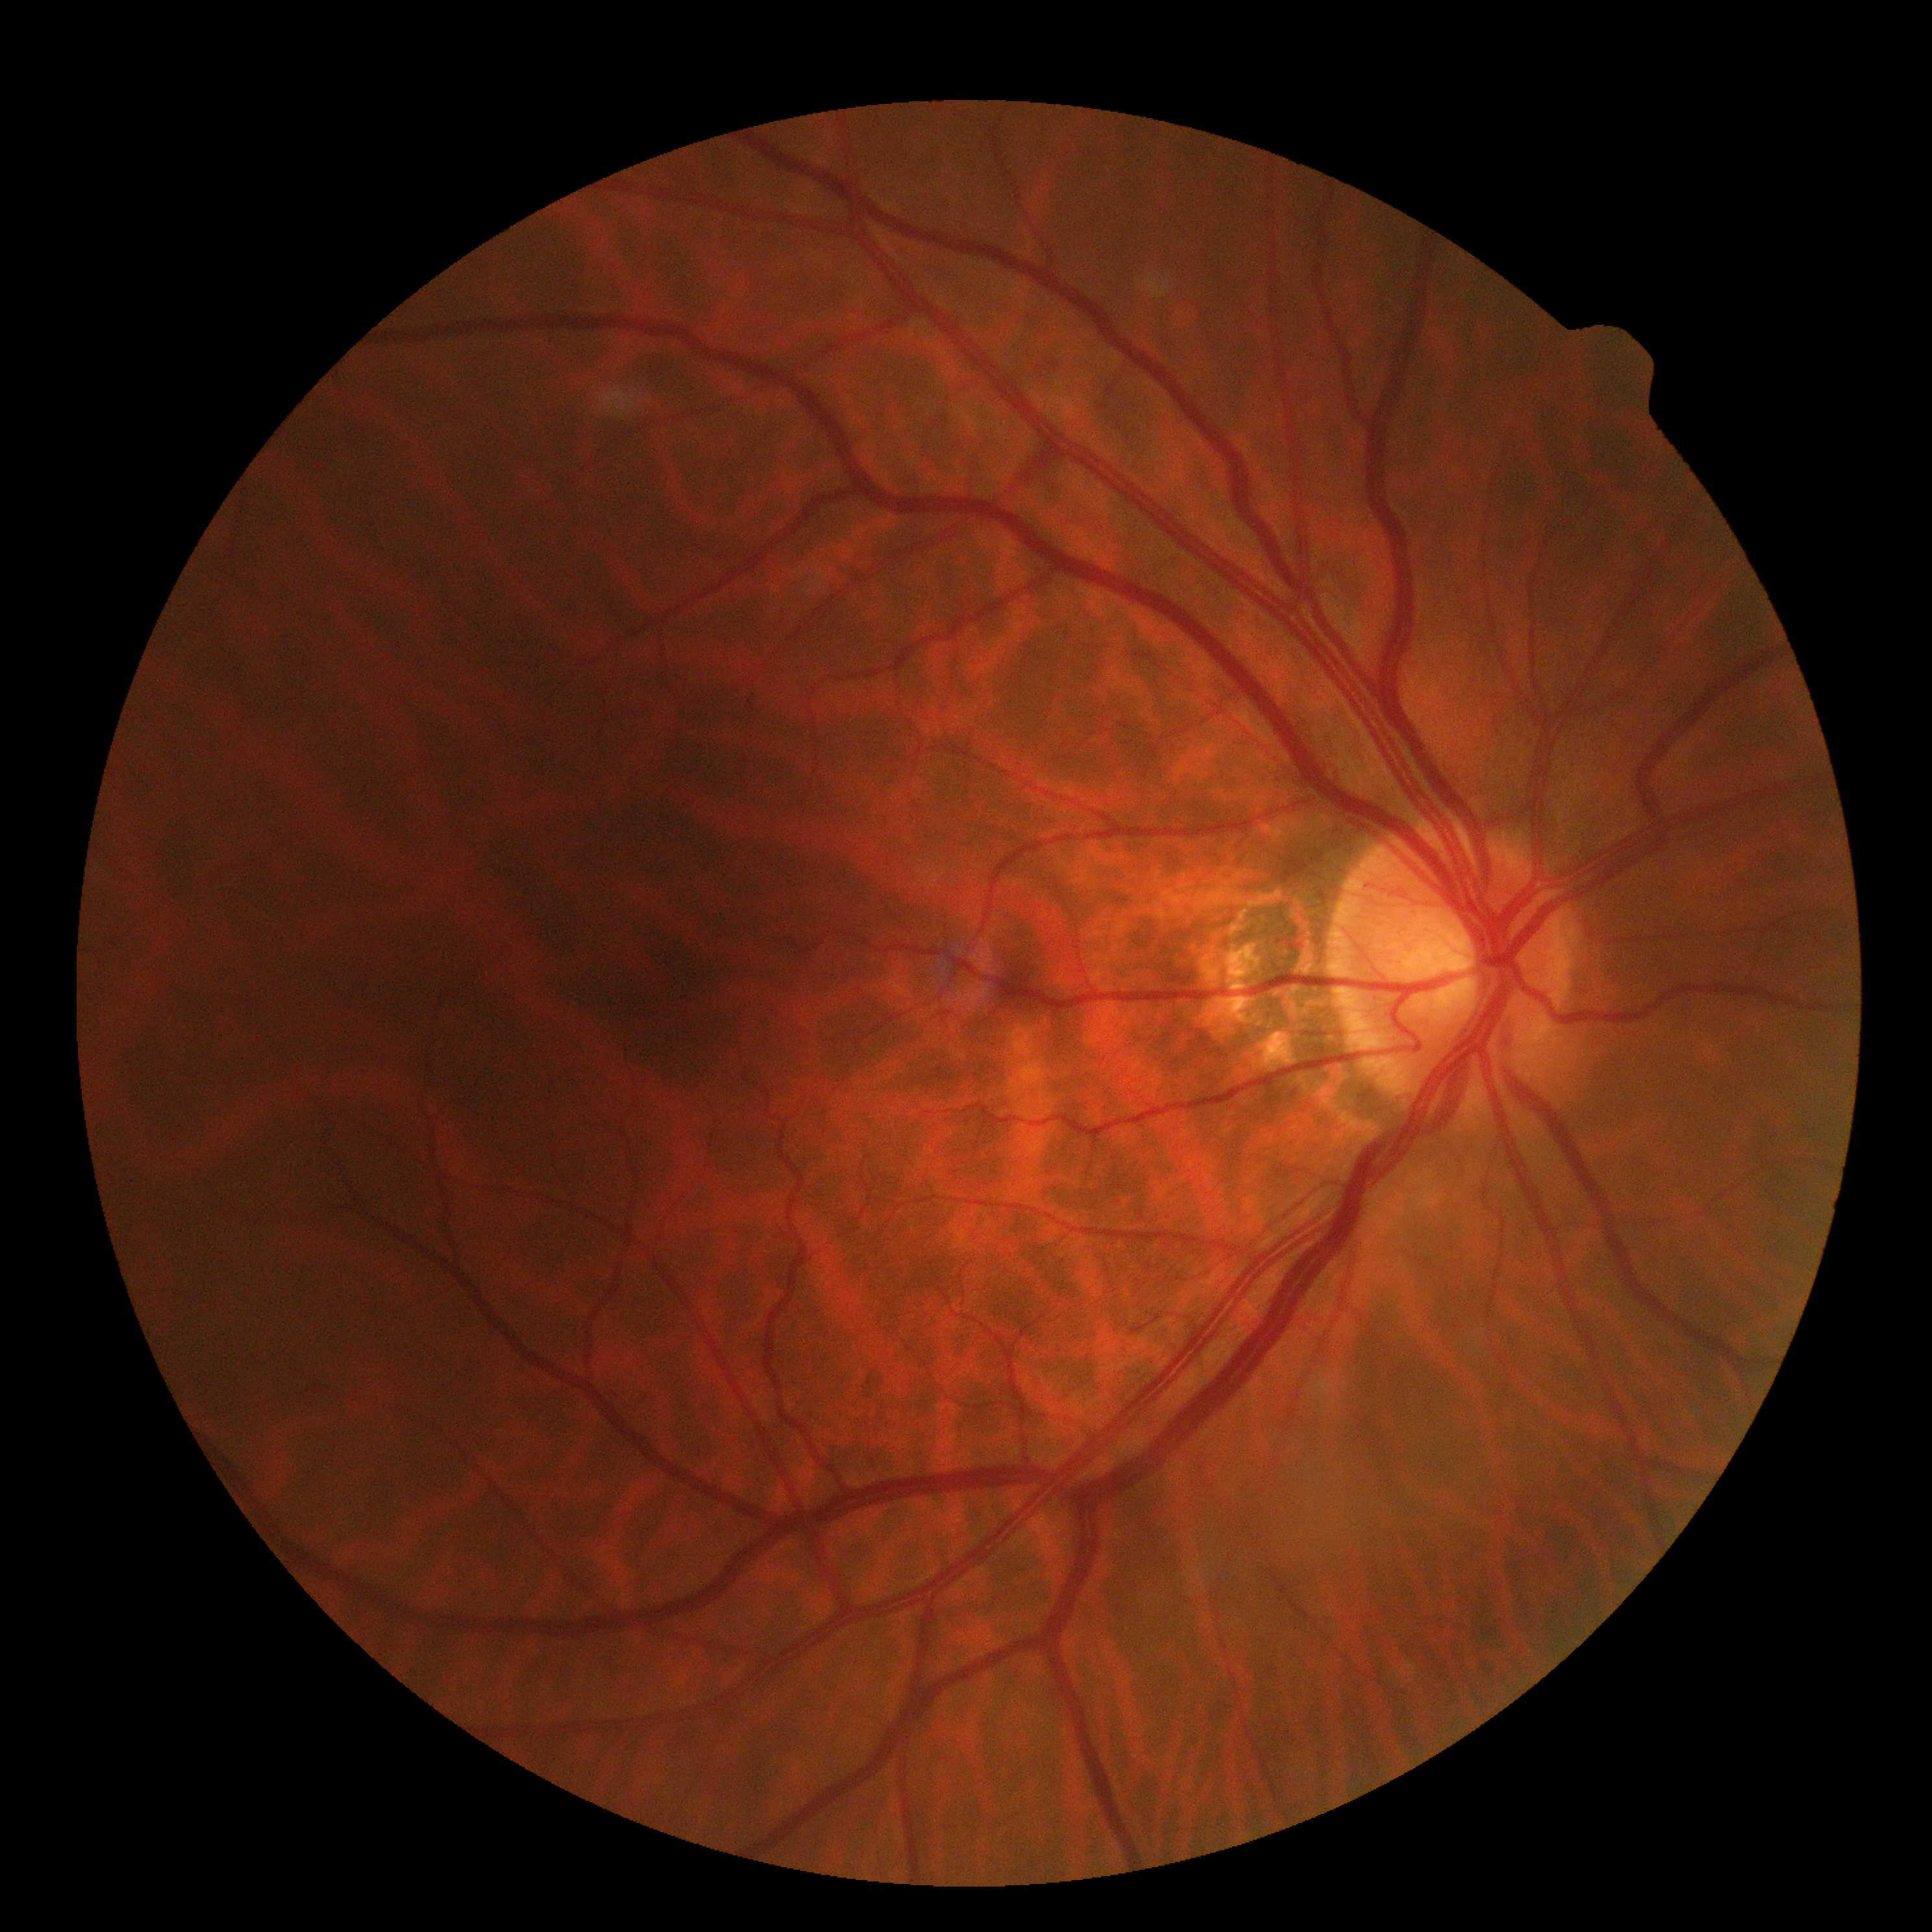
Retinopathy grade is 0.